Modified Davis classification:
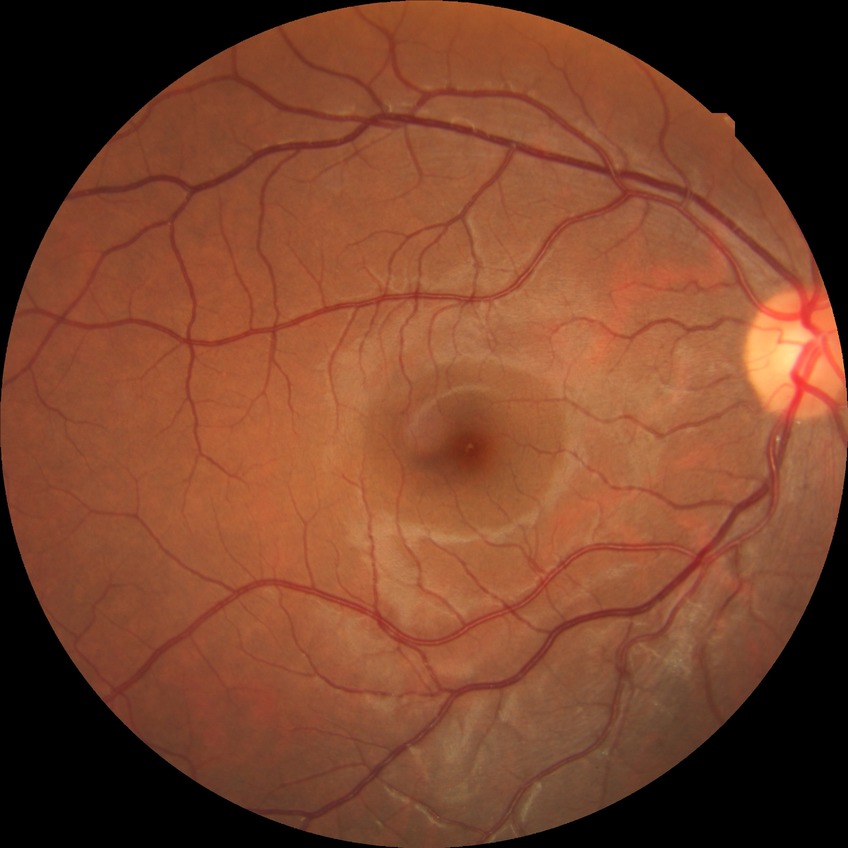 Diabetic retinopathy (DR): no diabetic retinopathy (NDR).